Wide-field fundus photograph from neonatal ROP screening; 1240 x 1240 pixels: 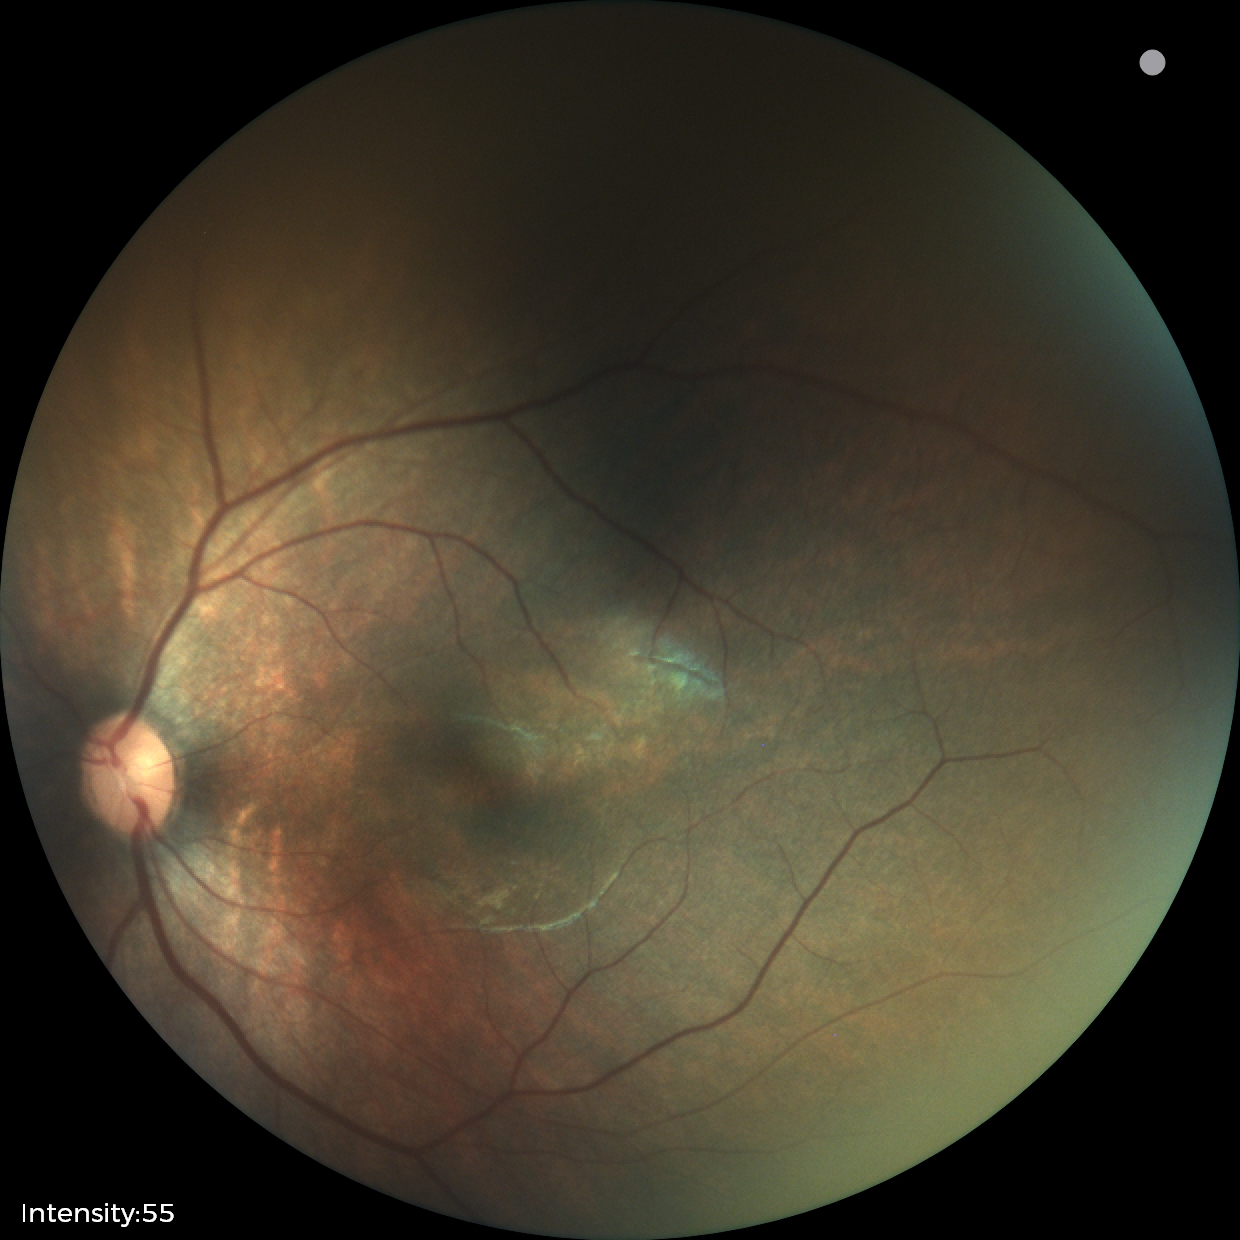
Impression = normal retinal appearance.